640x480. Infant wide-field fundus photograph.
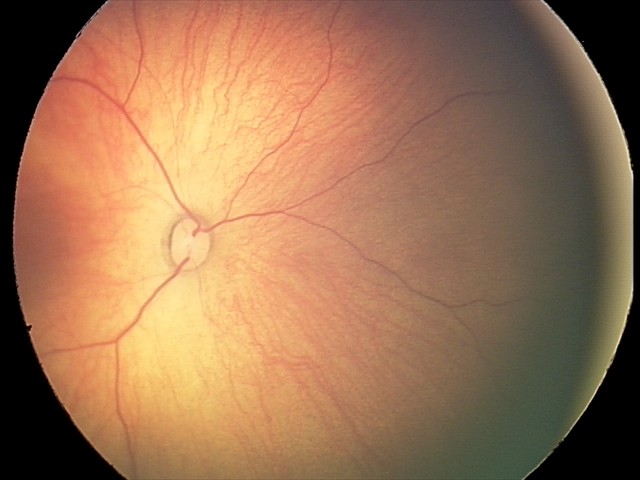
Assessment: retinal hemorrhages.